NIDEK AFC-230, nonmydriatic fundus photograph
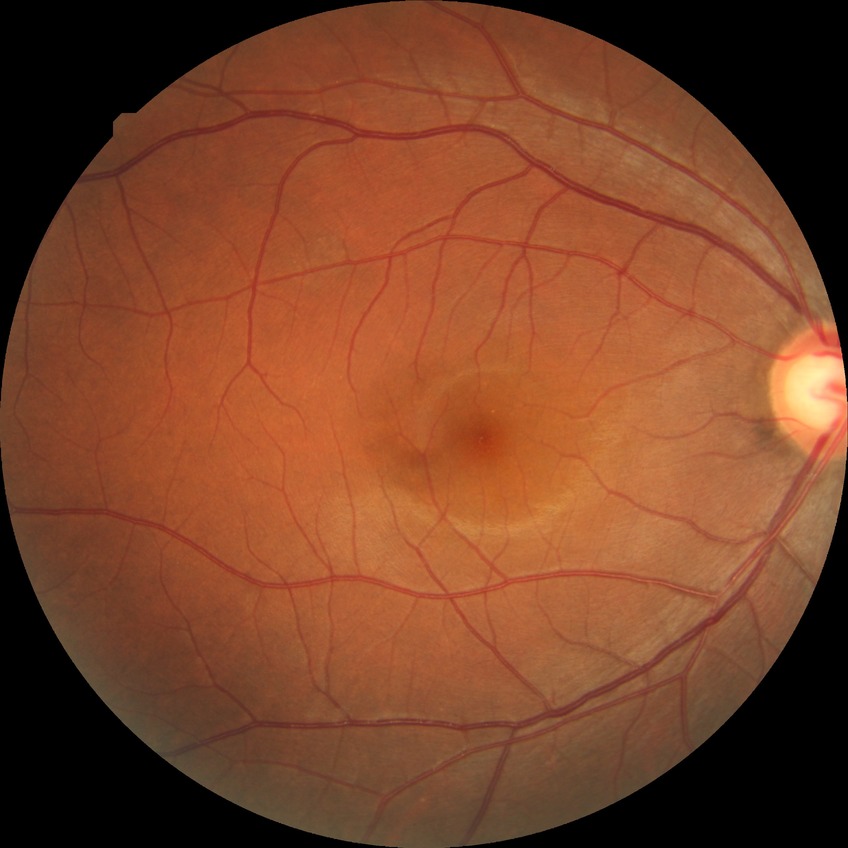
DR impression = no apparent DR; DR grade = NDR.